2352 x 1568 pixels:
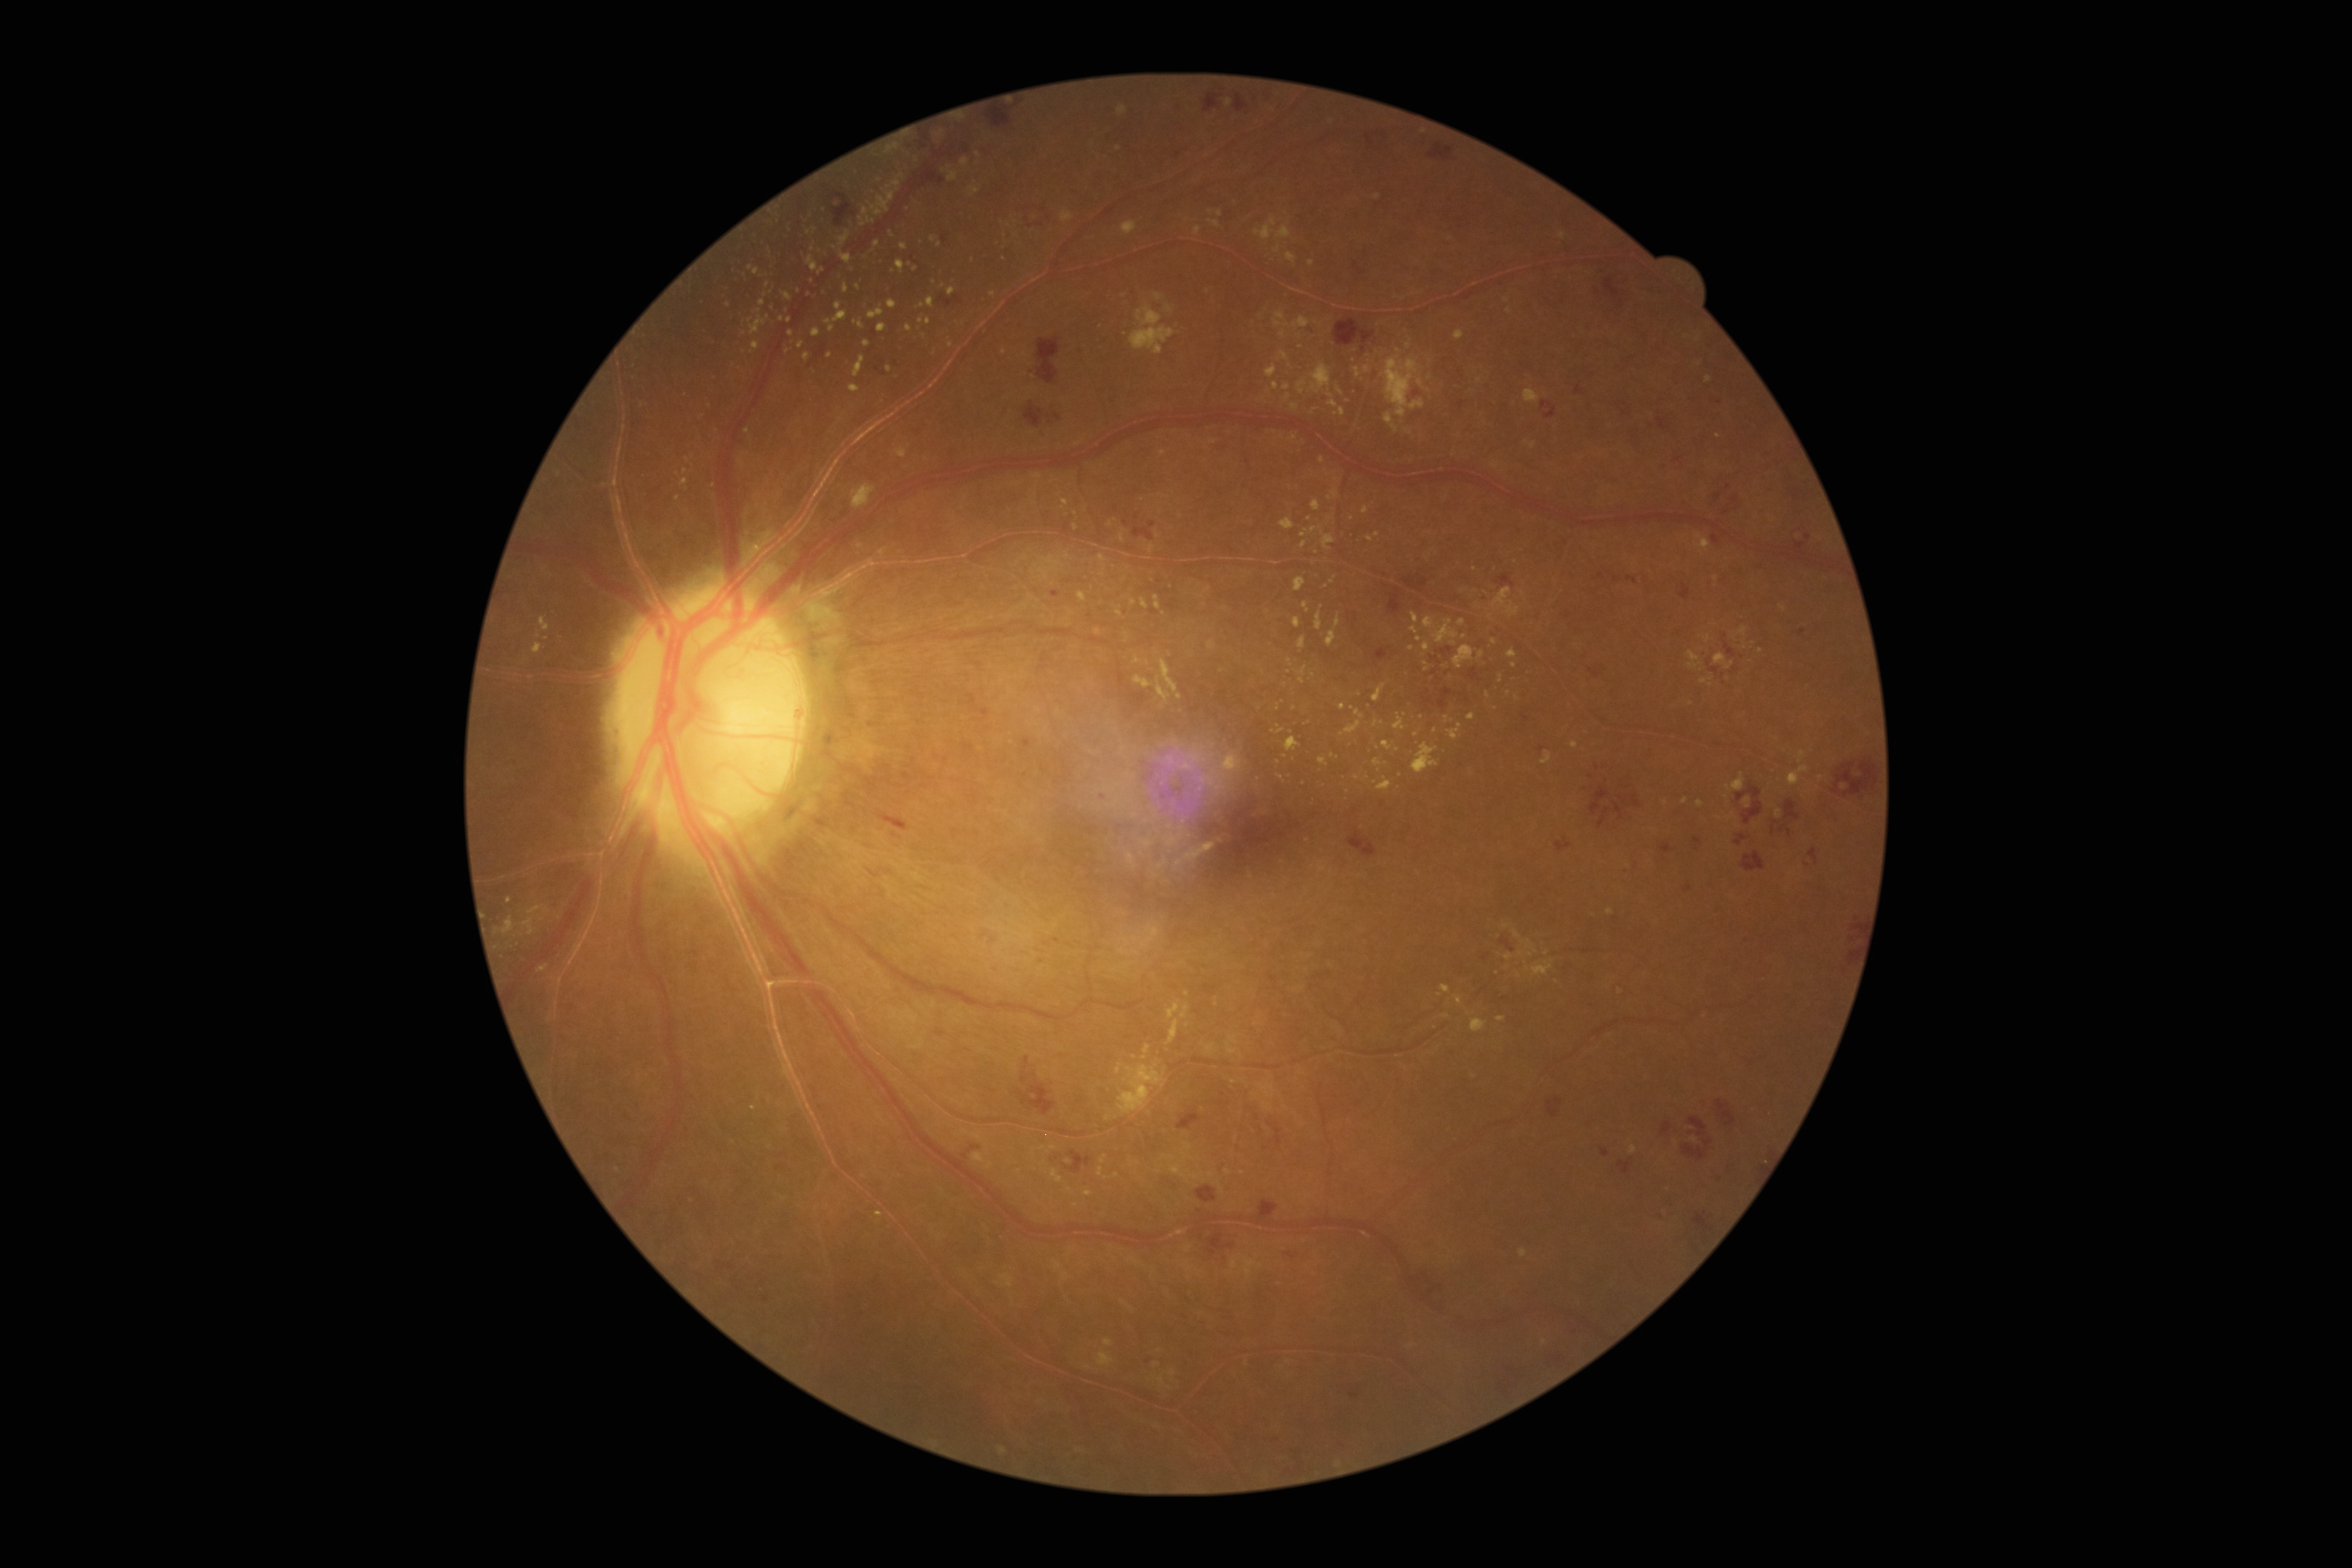

DR severity: severe non-proliferative diabetic retinopathy (grade 3).